45-degree field of view, 2352 by 1568 pixels, retinal fundus photograph:
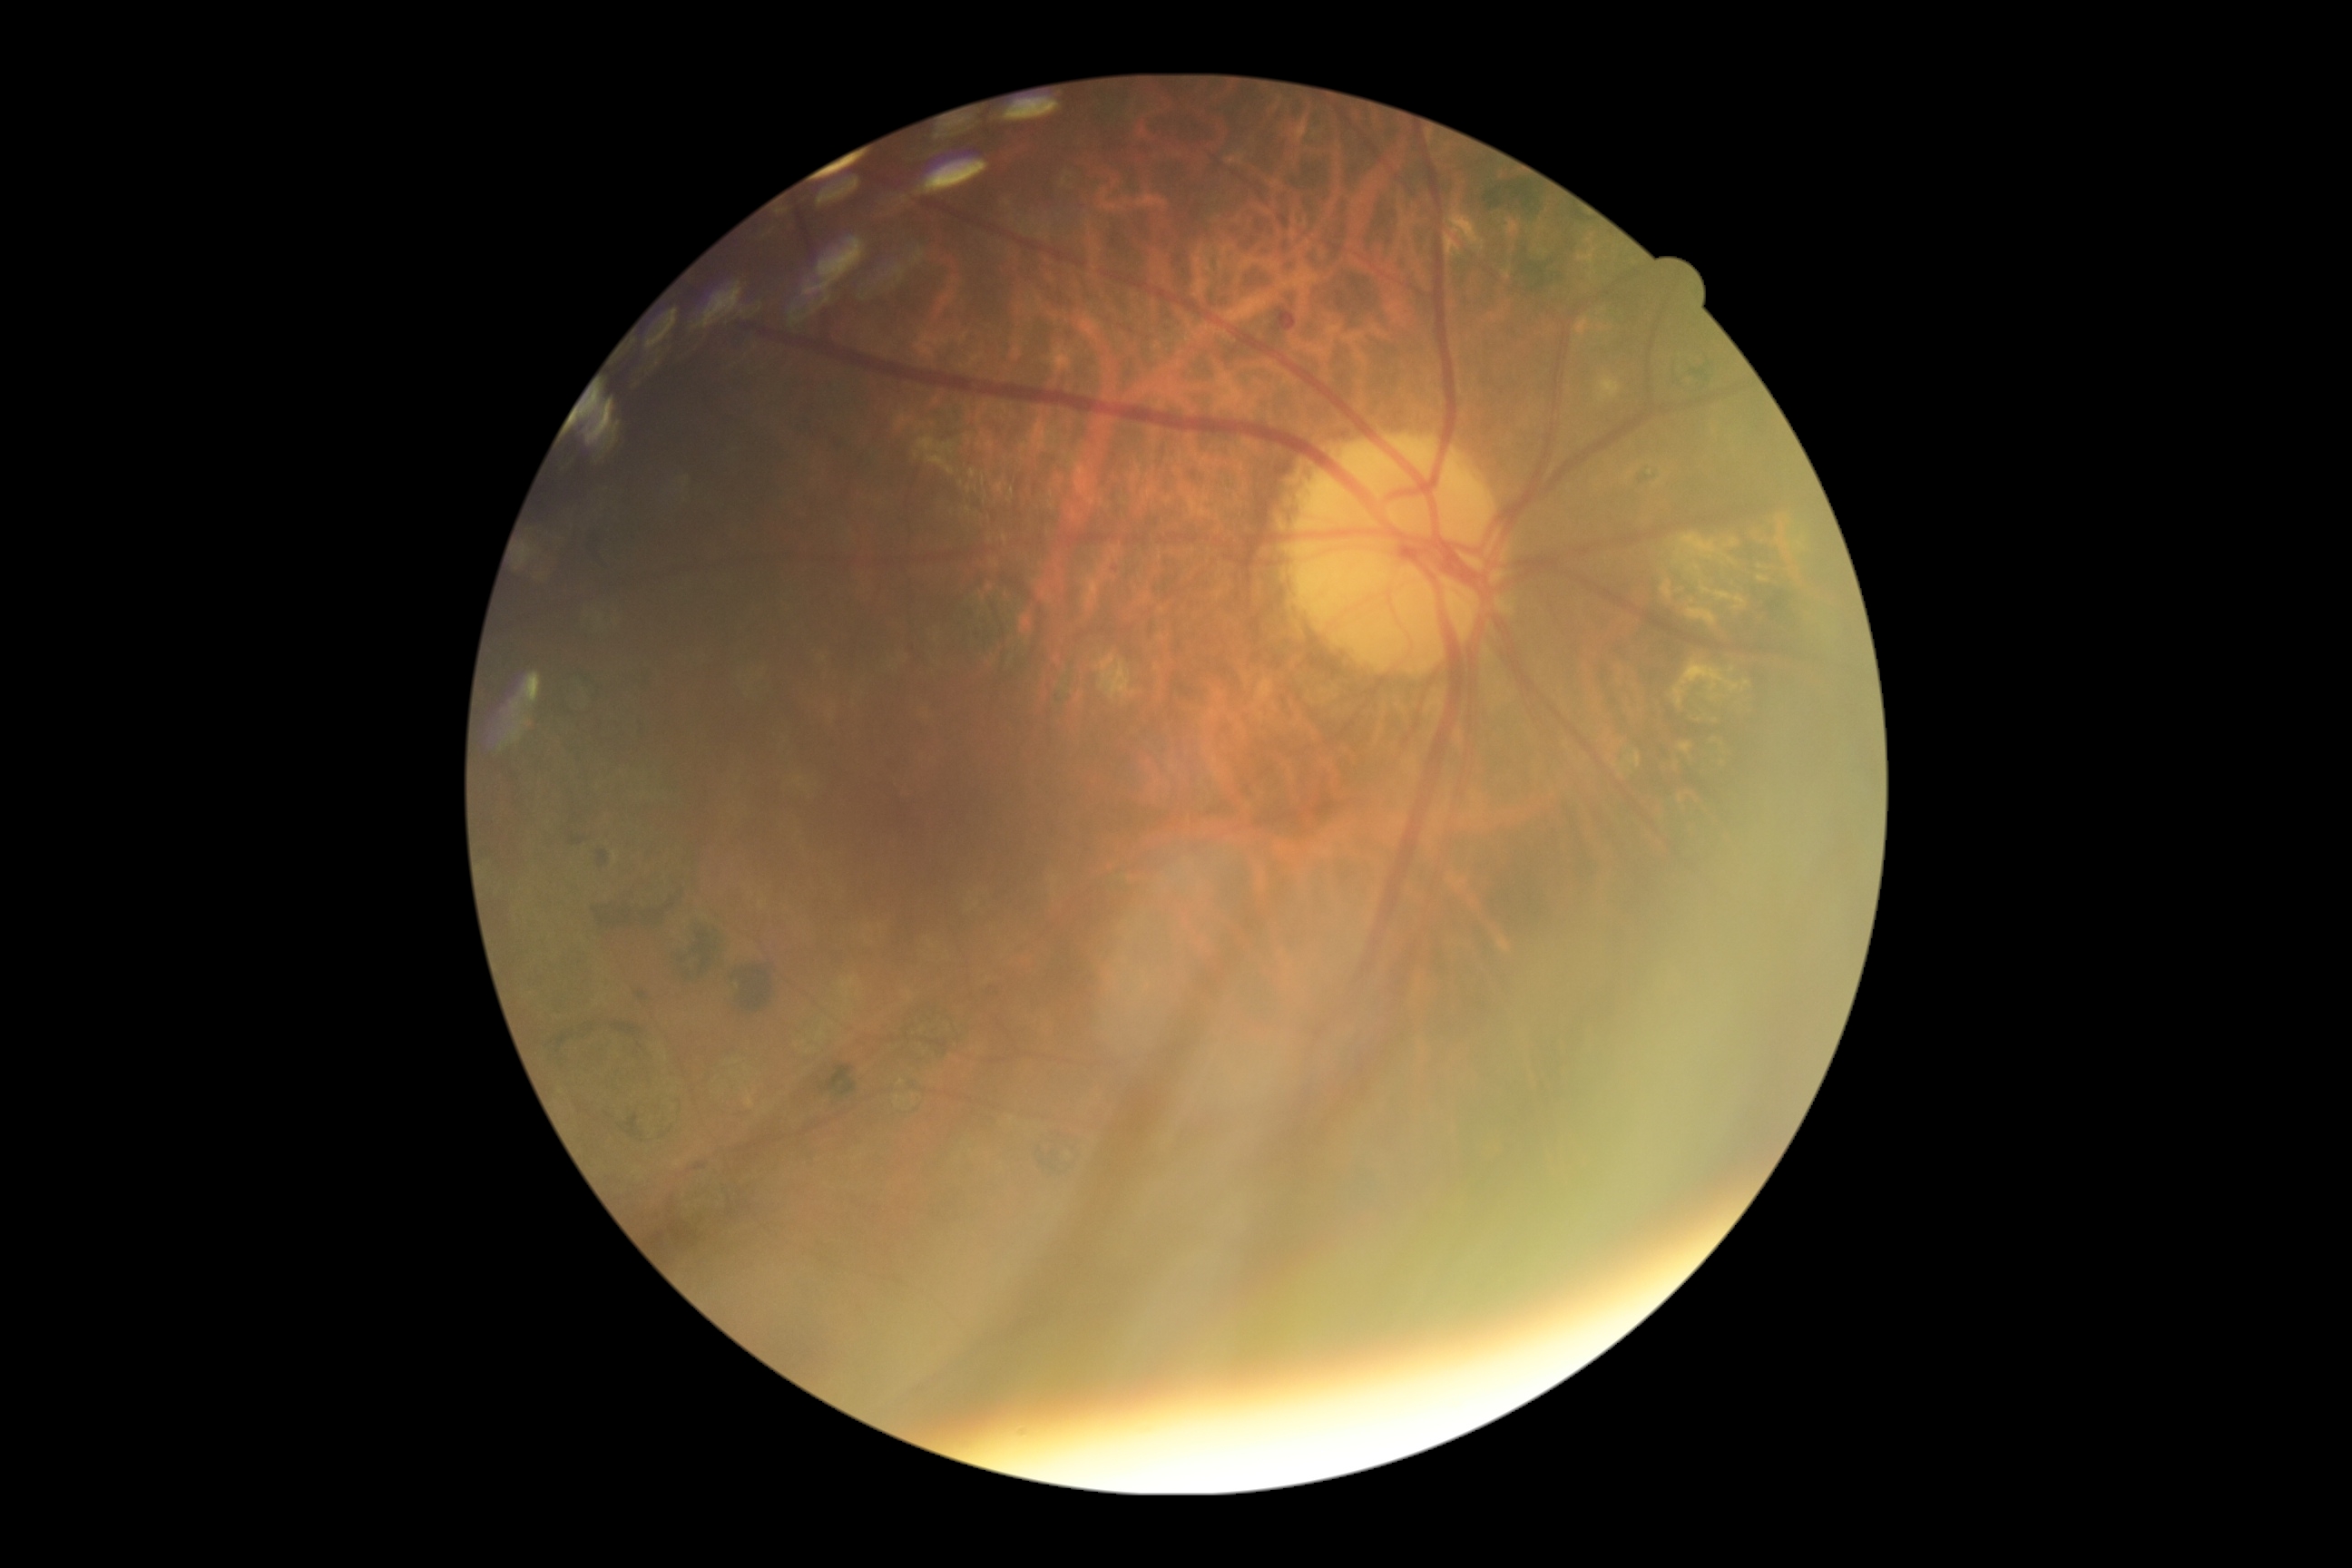 Diabetic retinopathy (DR): moderate NPDR (grade 2) — more than just microaneurysms but less than severe NPDR.